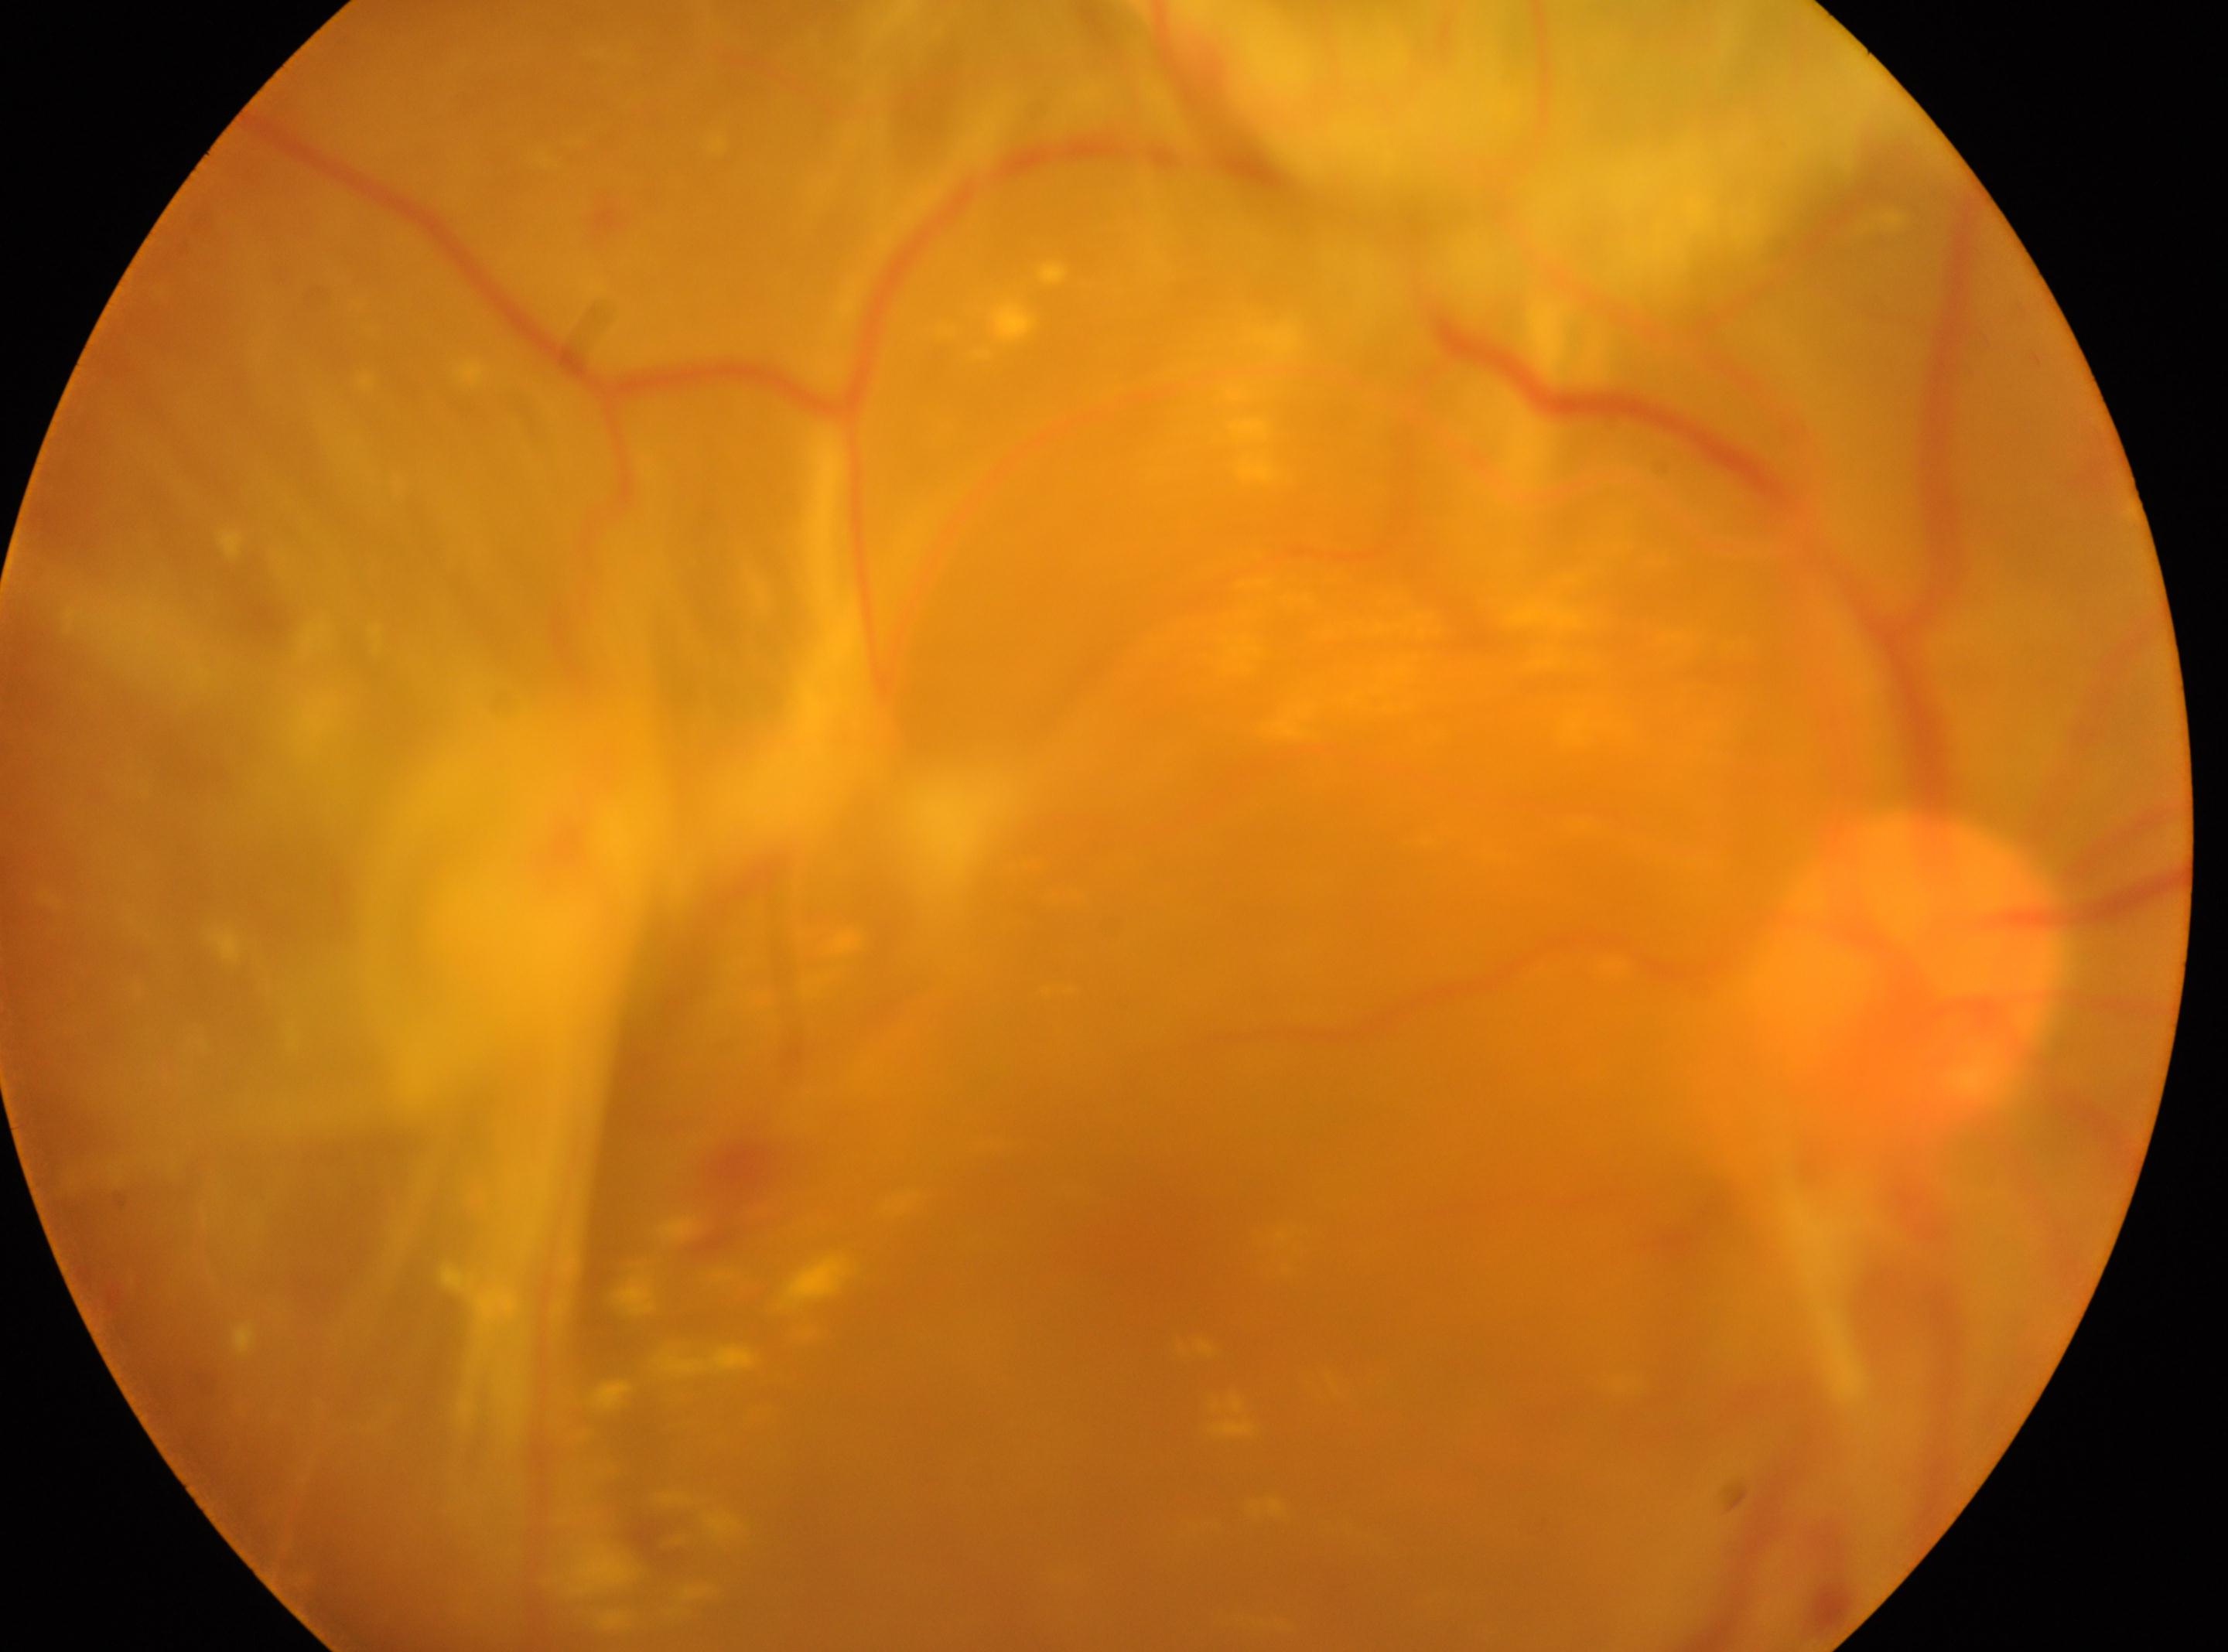
Eye: right eye. Retinopathy: PDR (grade 4). The foveal center is at 1162px, 1242px. Optic disc: 1903px, 978px.